DR severity per modified Davis staging — 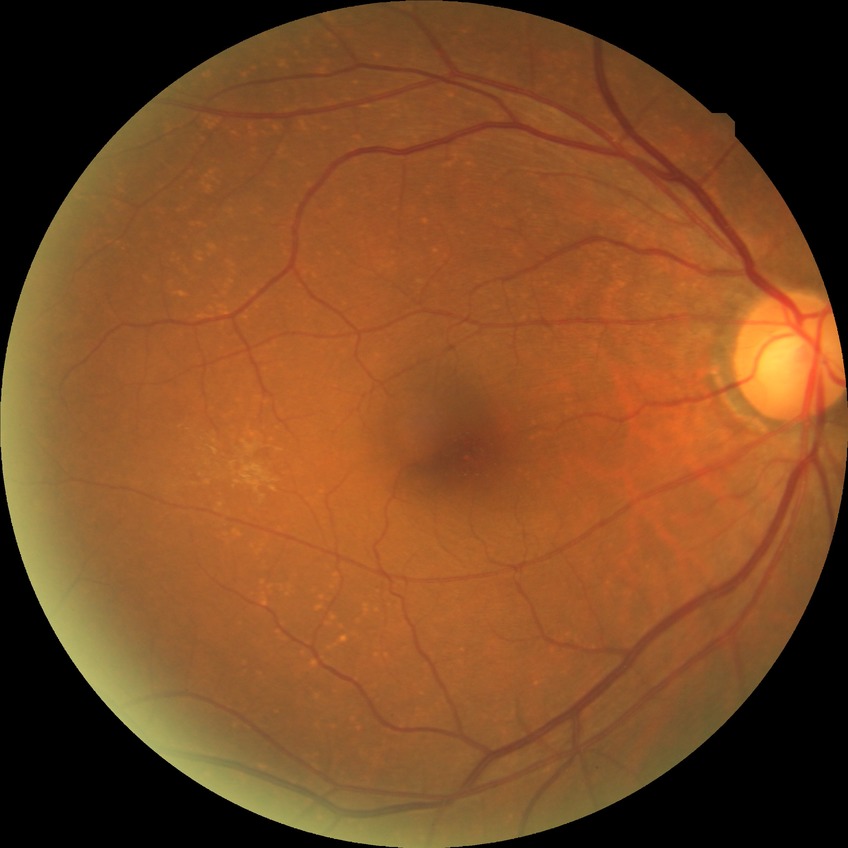
Davis grading: no diabetic retinopathy.